Wide-field contact fundus photograph of an infant. Captured with the Clarity RetCam 3 (130° field of view): 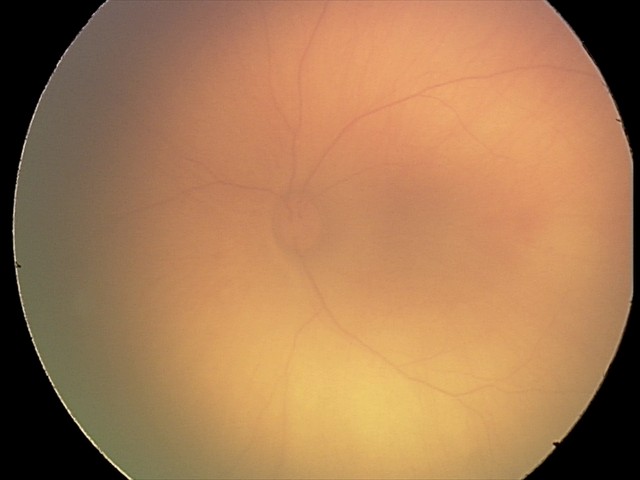
Assessment = retinal hemorrhages